Color fundus photograph centered on the optic disc.
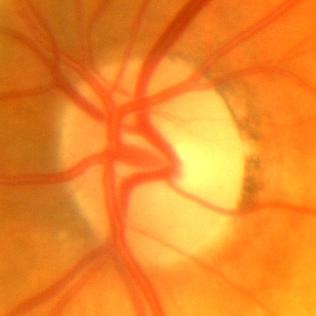 Demonstrates no glaucoma.